Captured on a Topcon TRC-50DX fundus camera; 50° FOV; posterior pole view; retinal fundus photograph; dilated-pupil acquisition; 2228x1652:
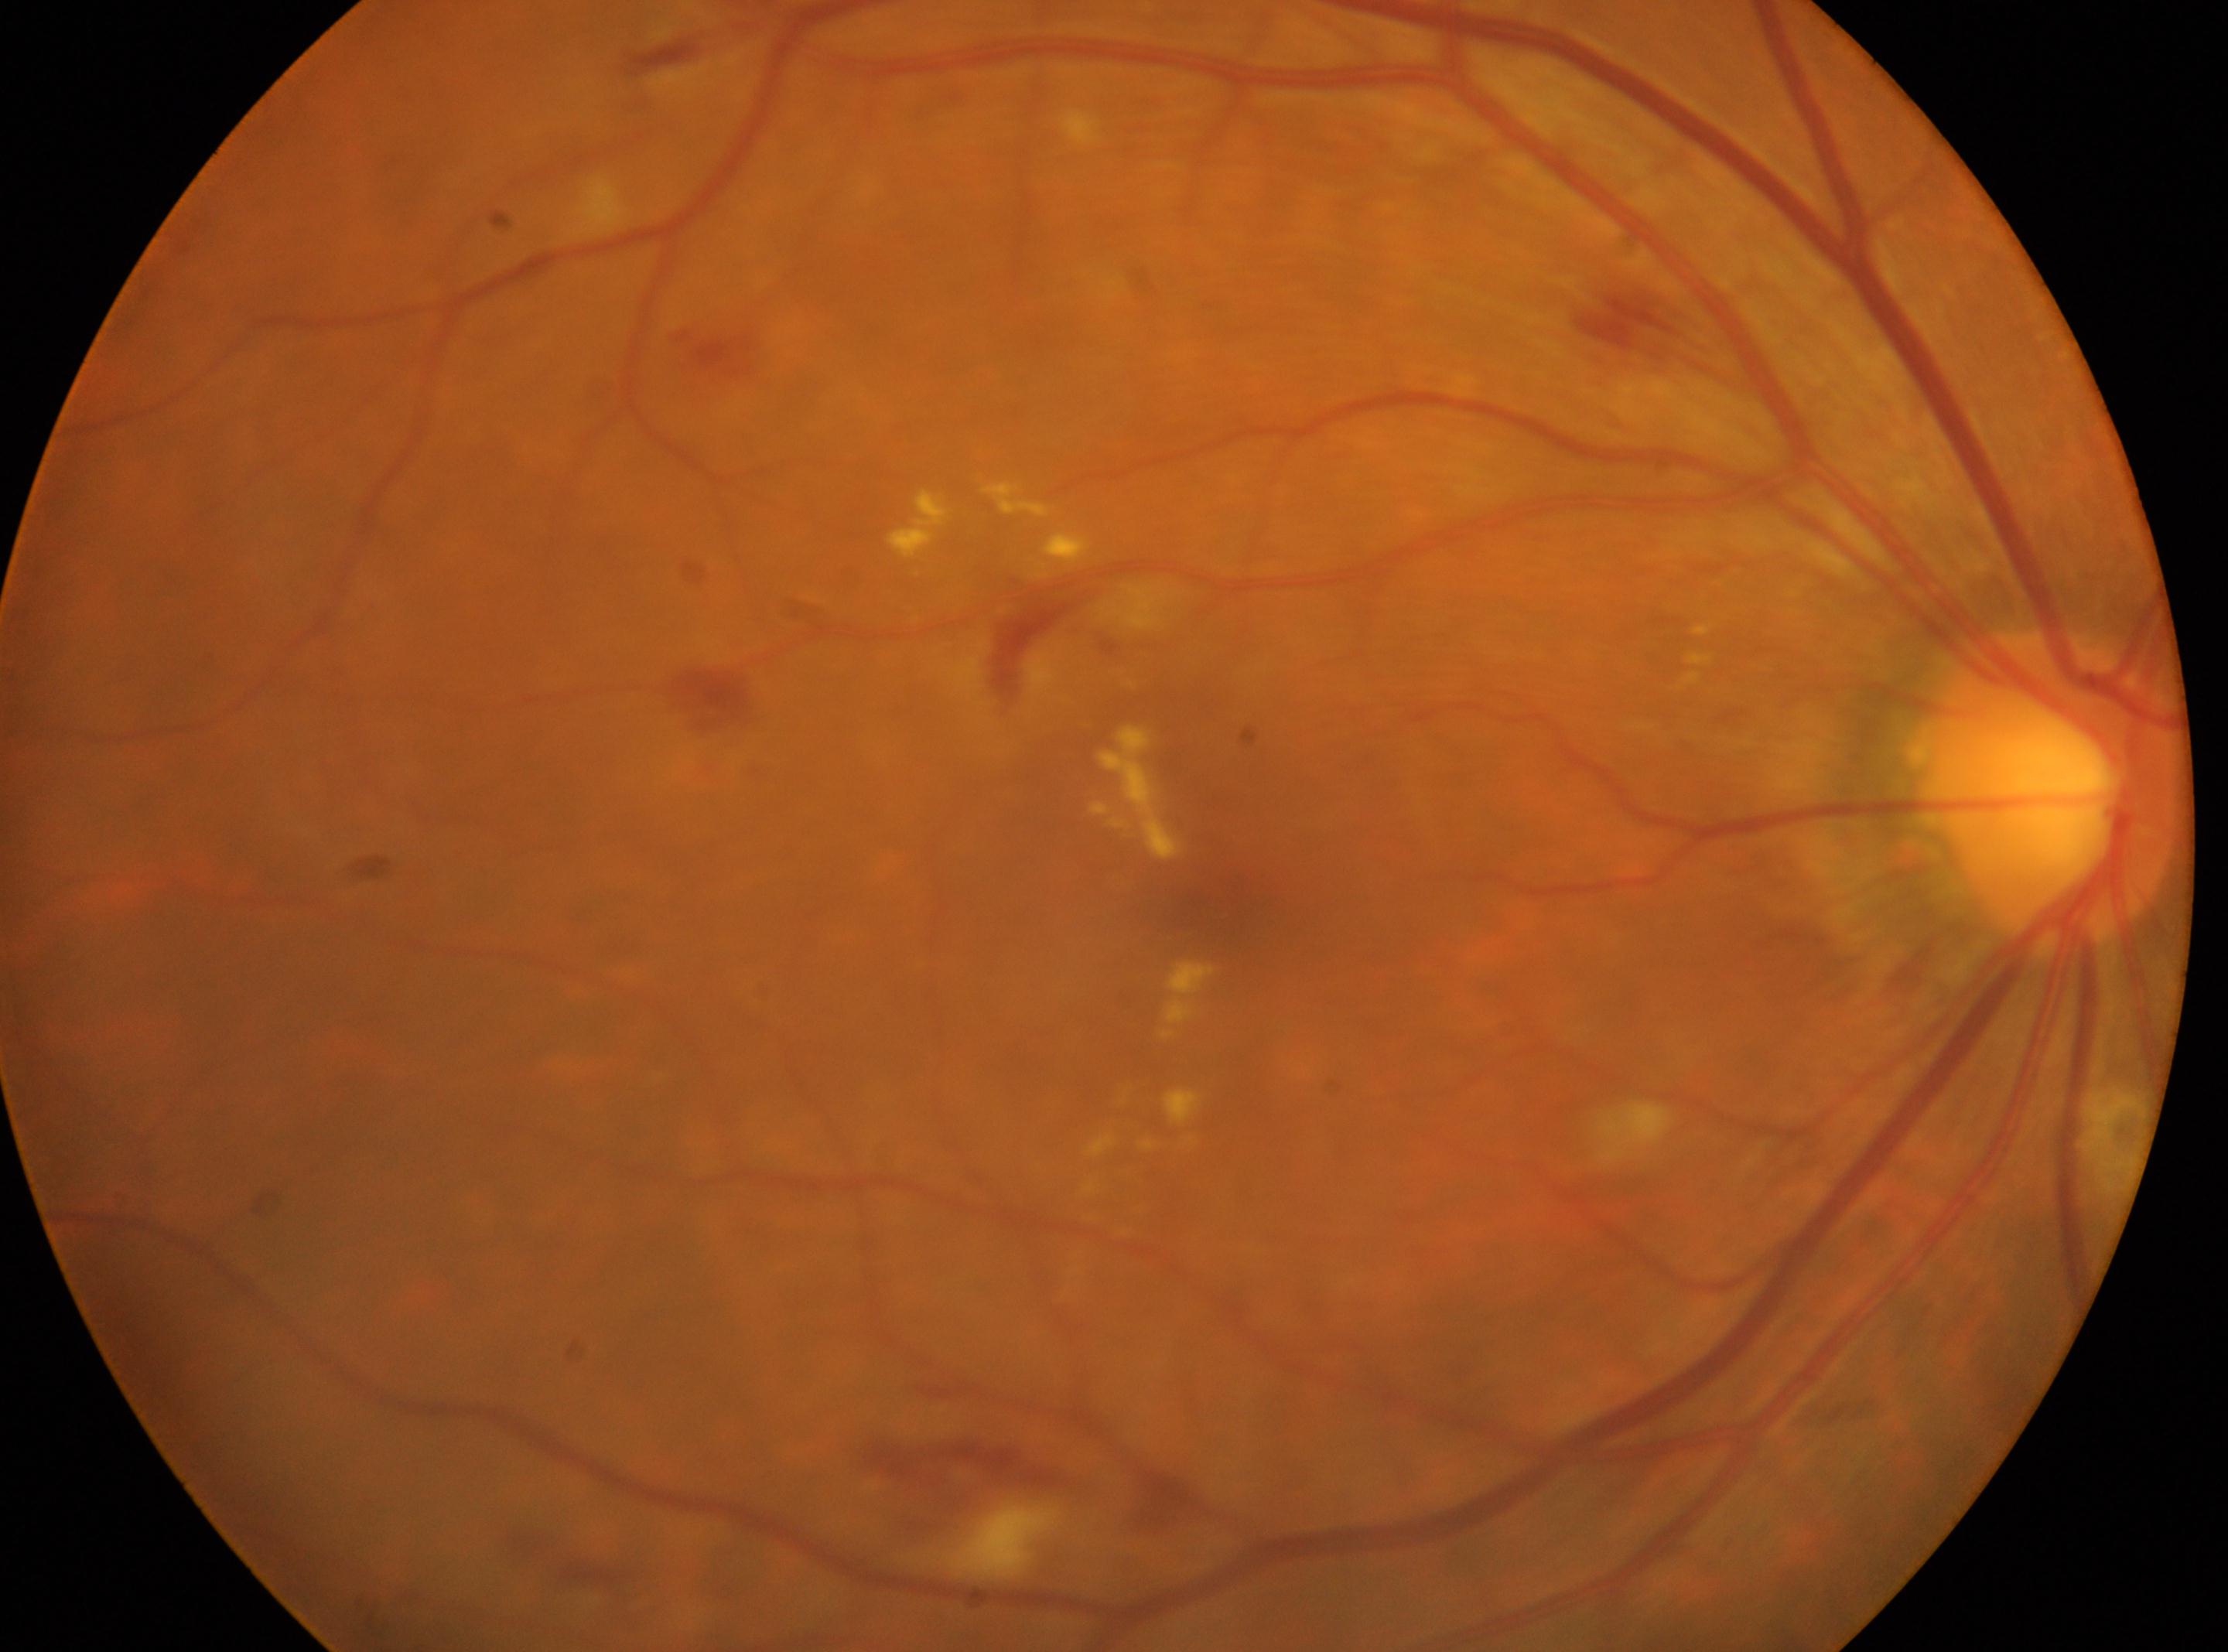 optic_disc: (x=2055, y=790)
eye: oculus dexter
dr_category: non-proliferative diabetic retinopathy
fovea: (x=1215, y=908)
dr_grade: 2 (moderate NPDR)